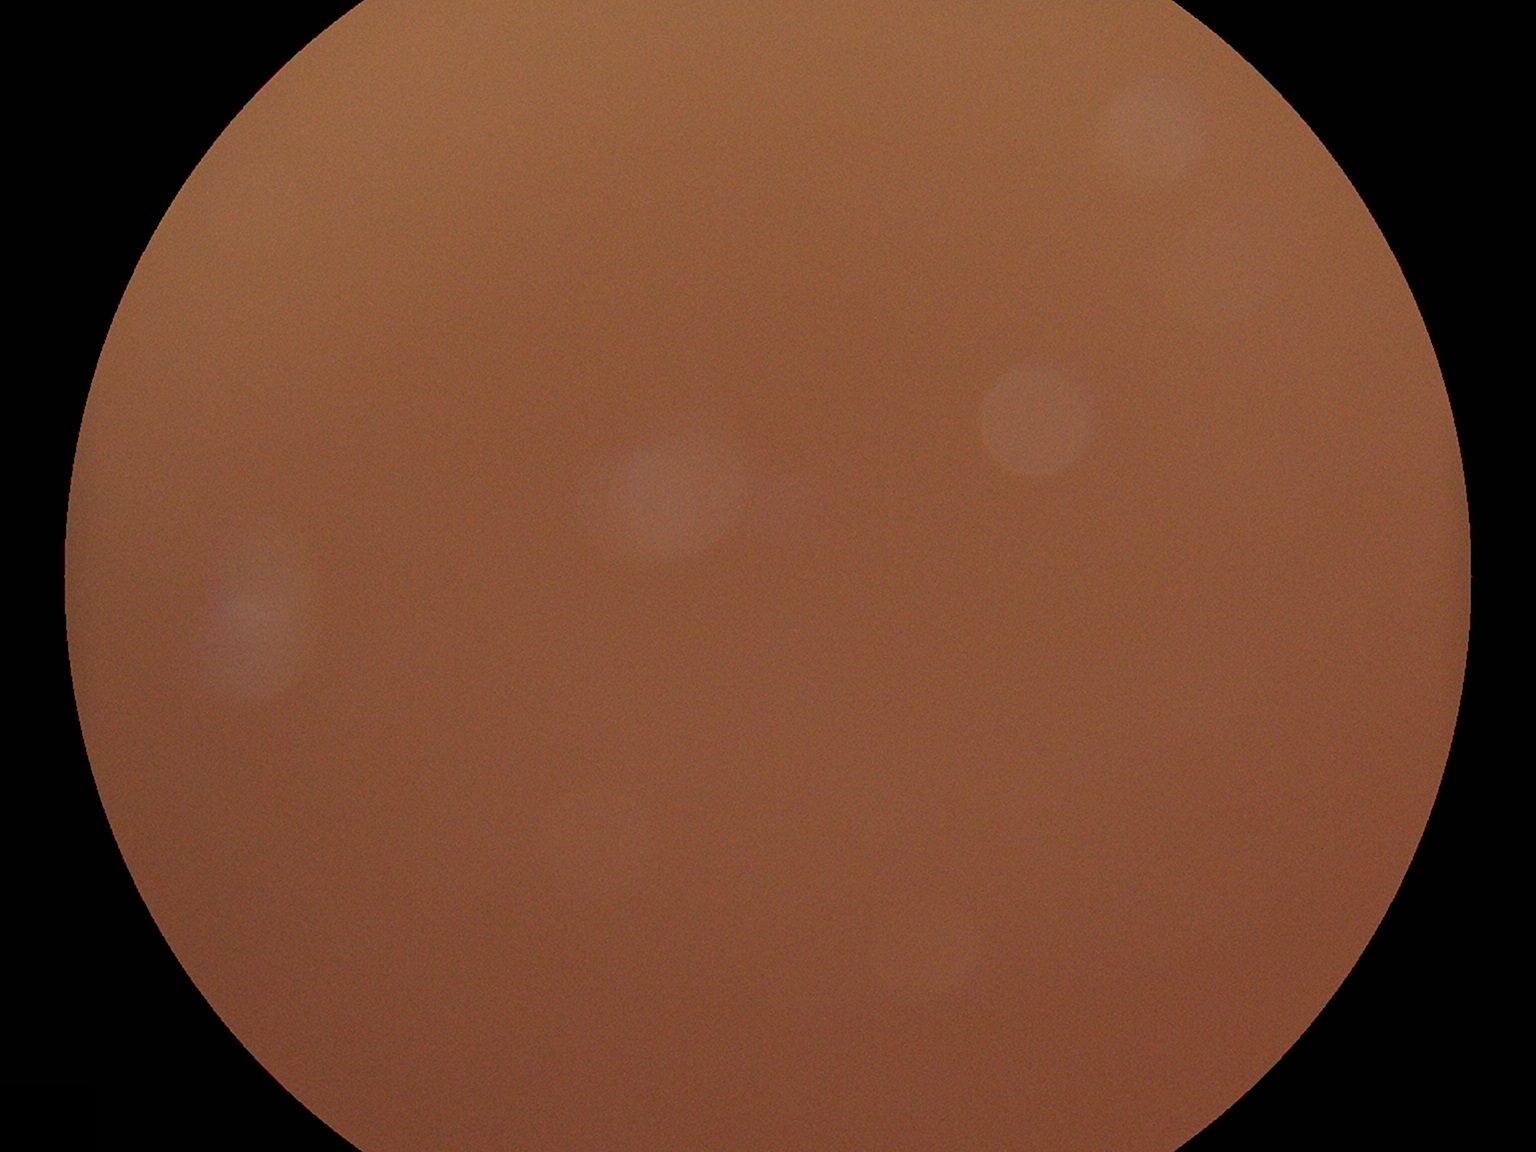
dr_grade: ungradable